Diabetic retinopathy graded by the modified Davis classification; FOV: 45 degrees — 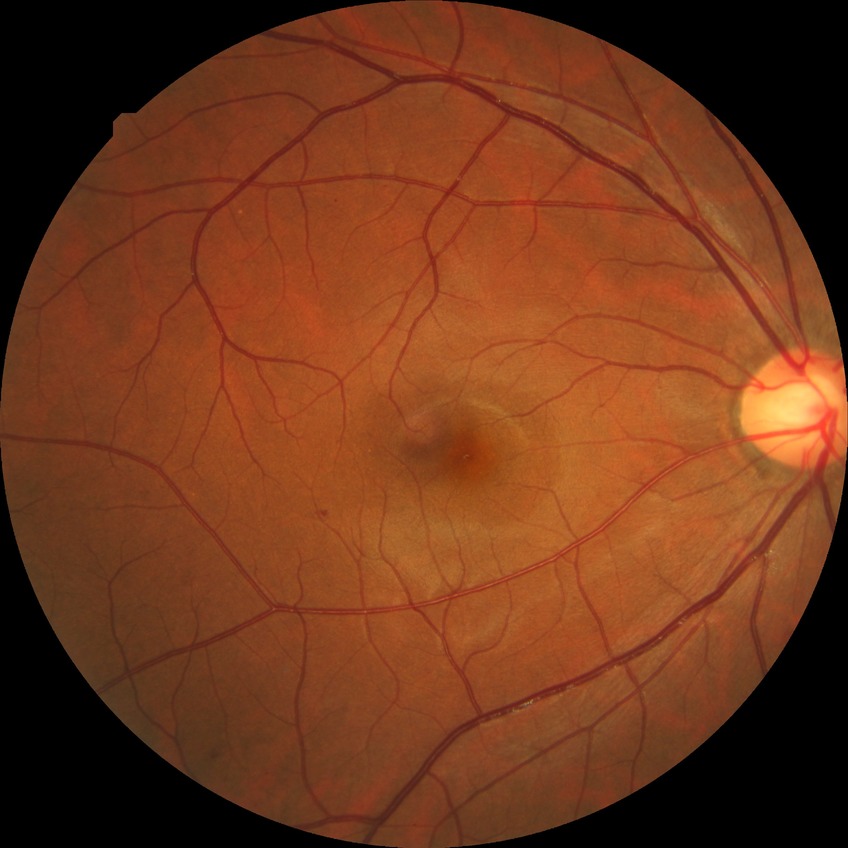

Disease class: non-proliferative diabetic retinopathy. Davis DR grade: SDR.